Phoenix ICON wide-field infant fundus image
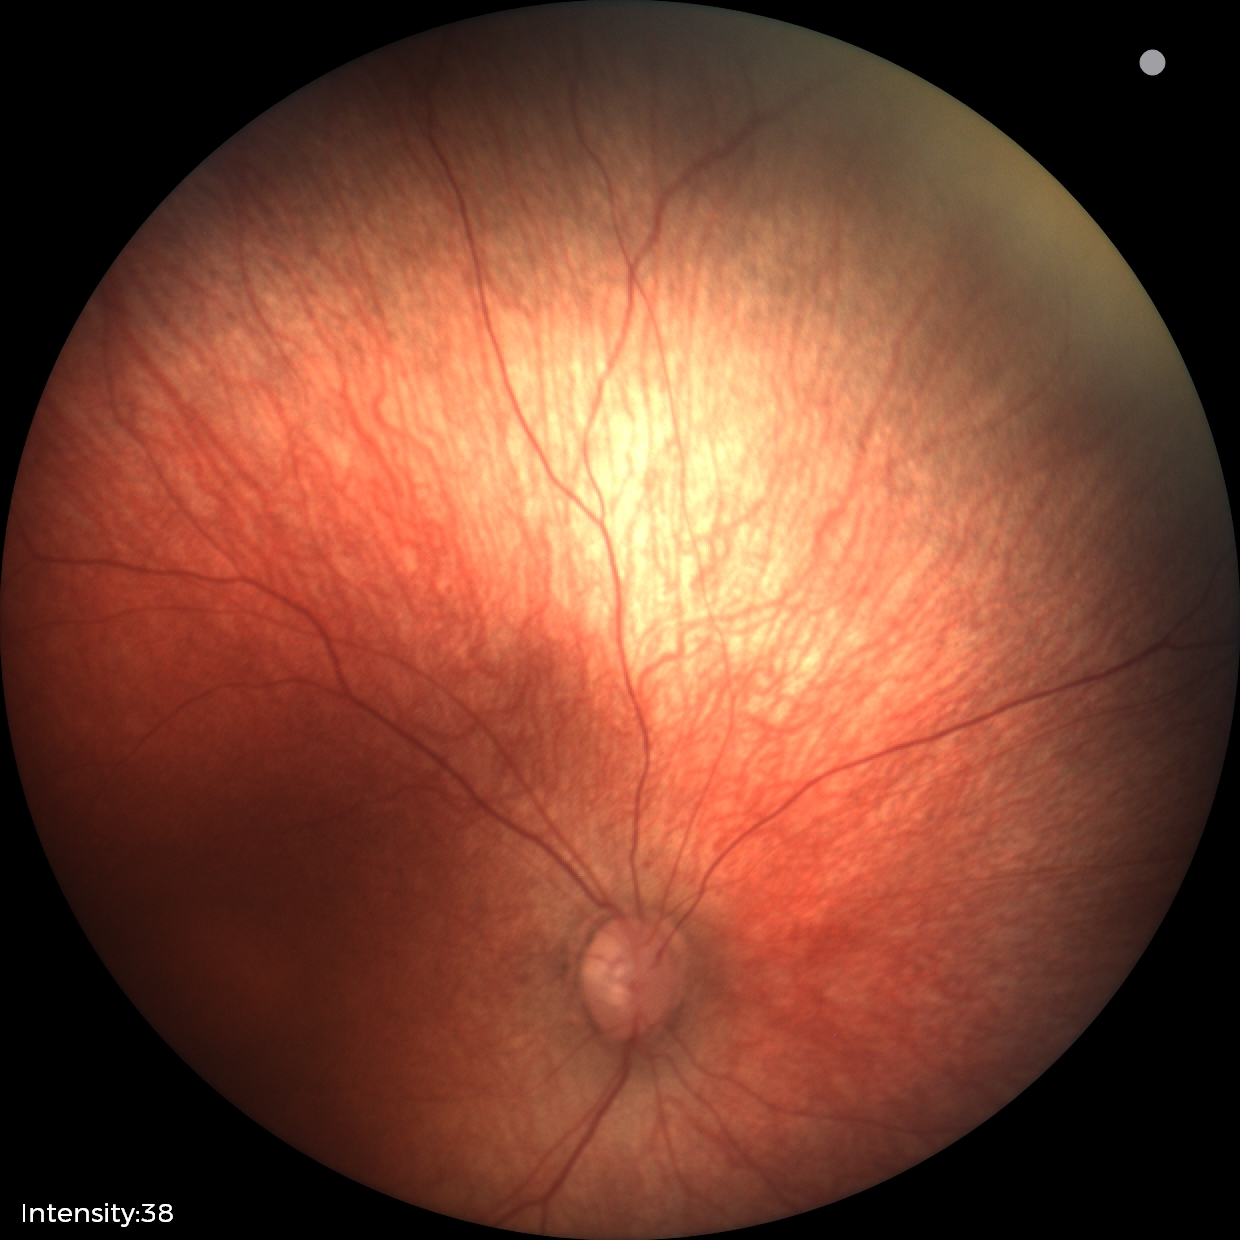
Physiological retinal appearance for postconceptual age.